Mydriatic (tropicamide 0.5%):
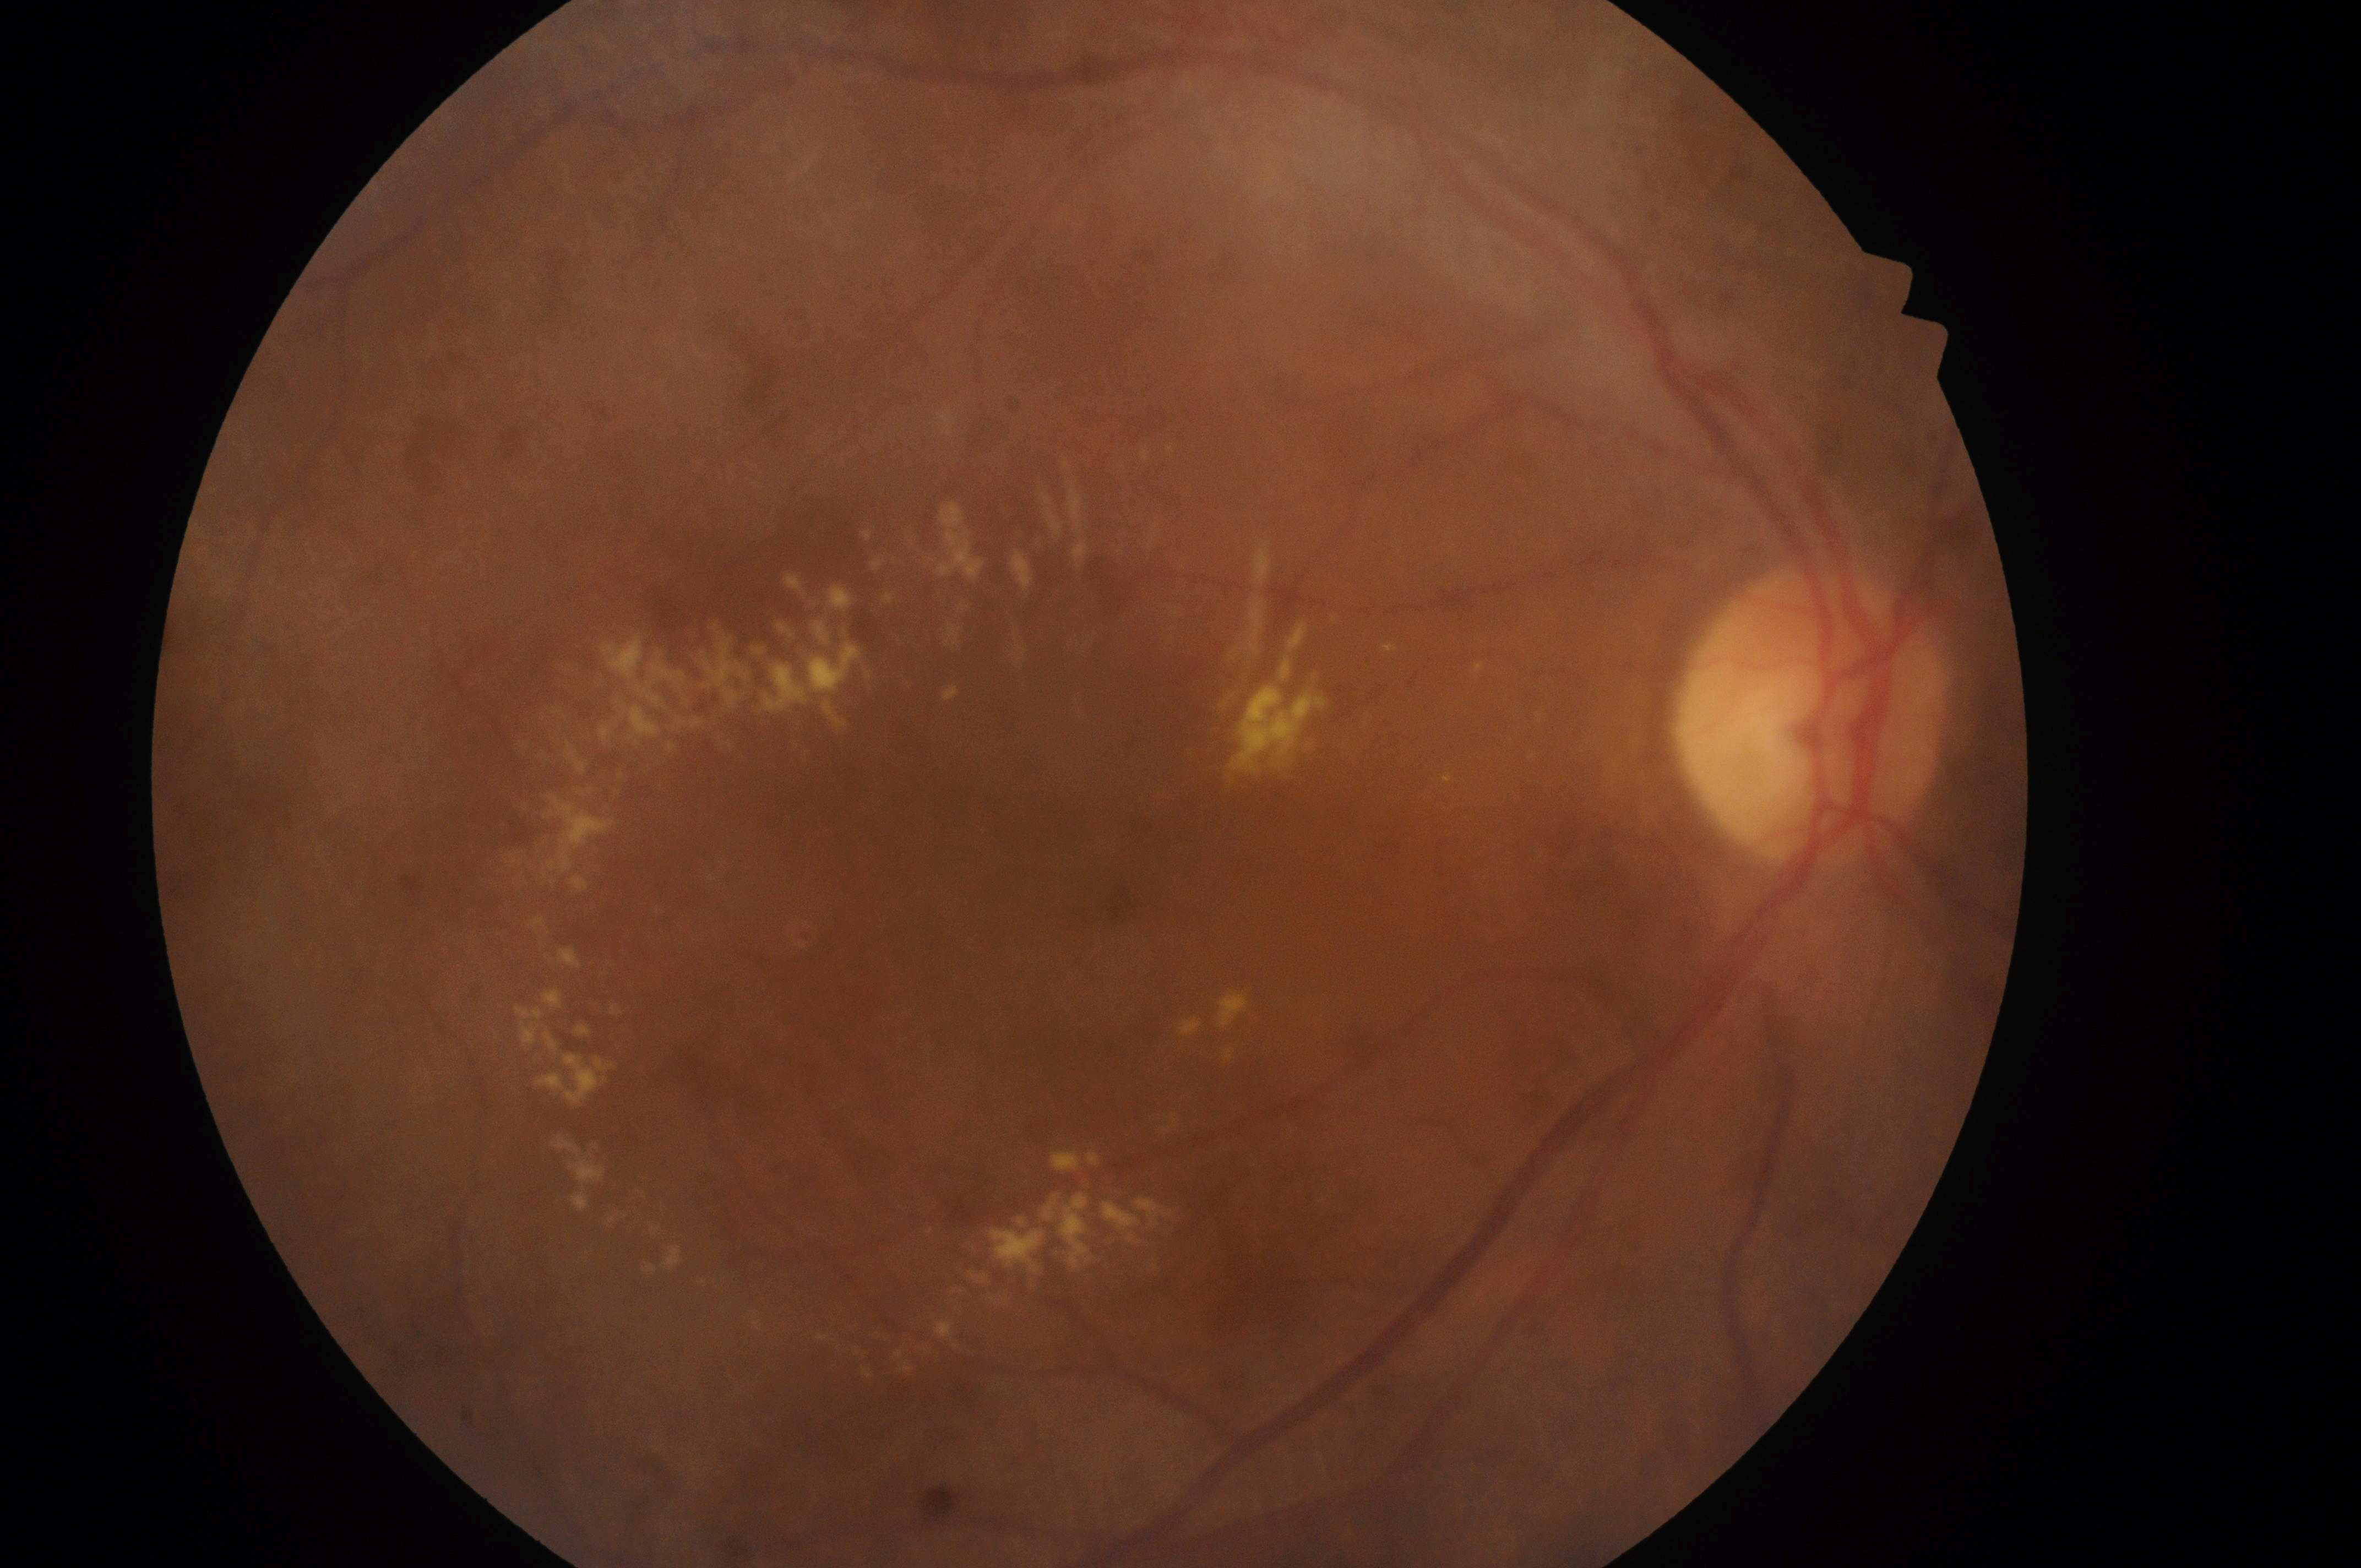
The fovea is at [1116, 905]. The retinopathy is classified as non-proliferative diabetic retinopathy. Eye: OD. The disc center is at [1809, 727]. Diabetic retinopathy (DR) is grade 2 (moderate NPDR). Diabetic macular edema (DME): grade 2 (high risk).